Without pupil dilation
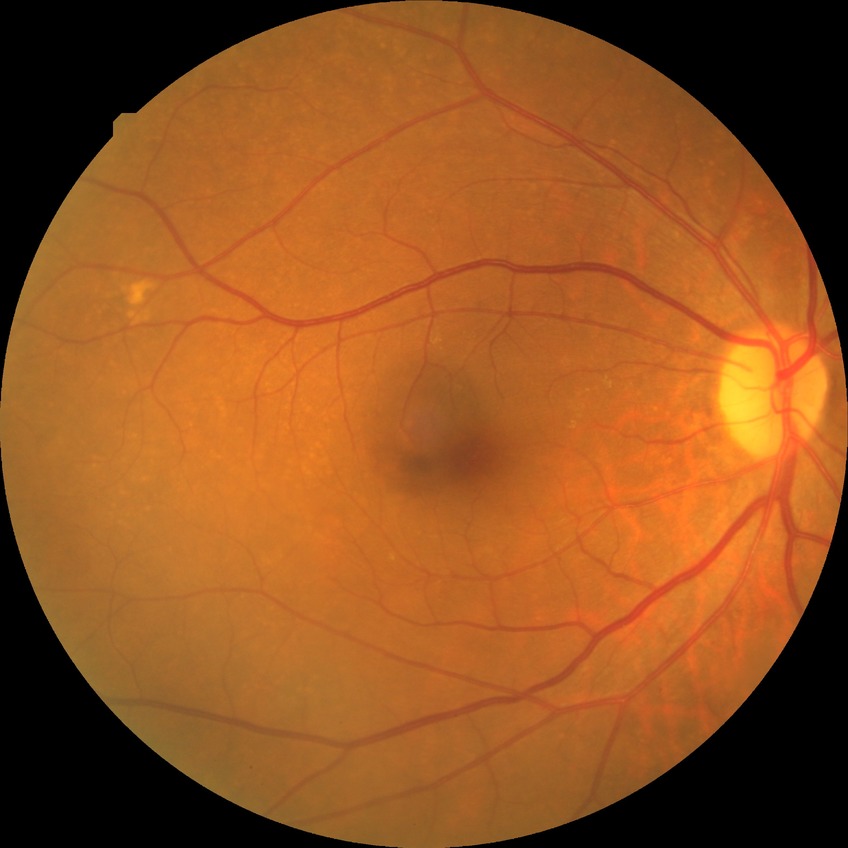
Annotations:
• DR stage — NDR